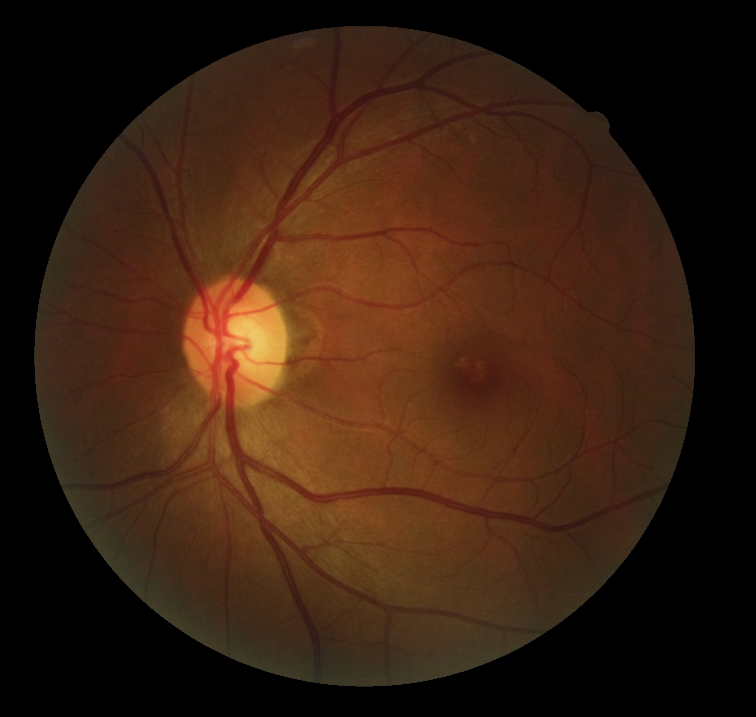

Findings:
– DR stage: grade 0